NIDEK AFC-230 · 848 x 848 pixels · 45-degree field of view · no pharmacologic dilation: 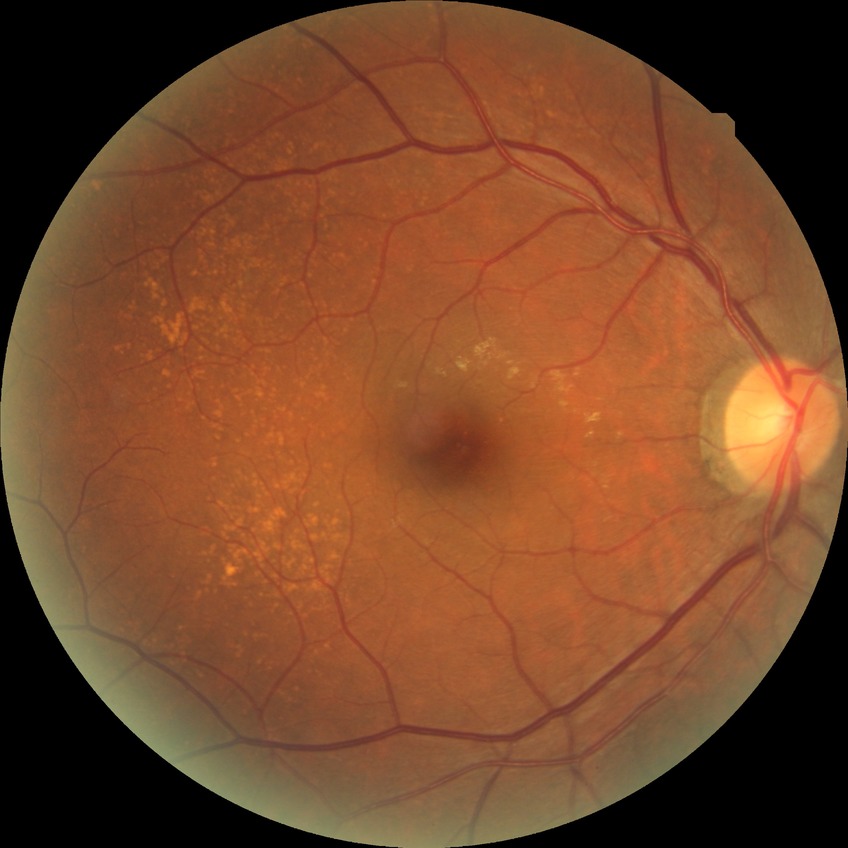

Assessment:
• modified Davis classification: no diabetic retinopathy